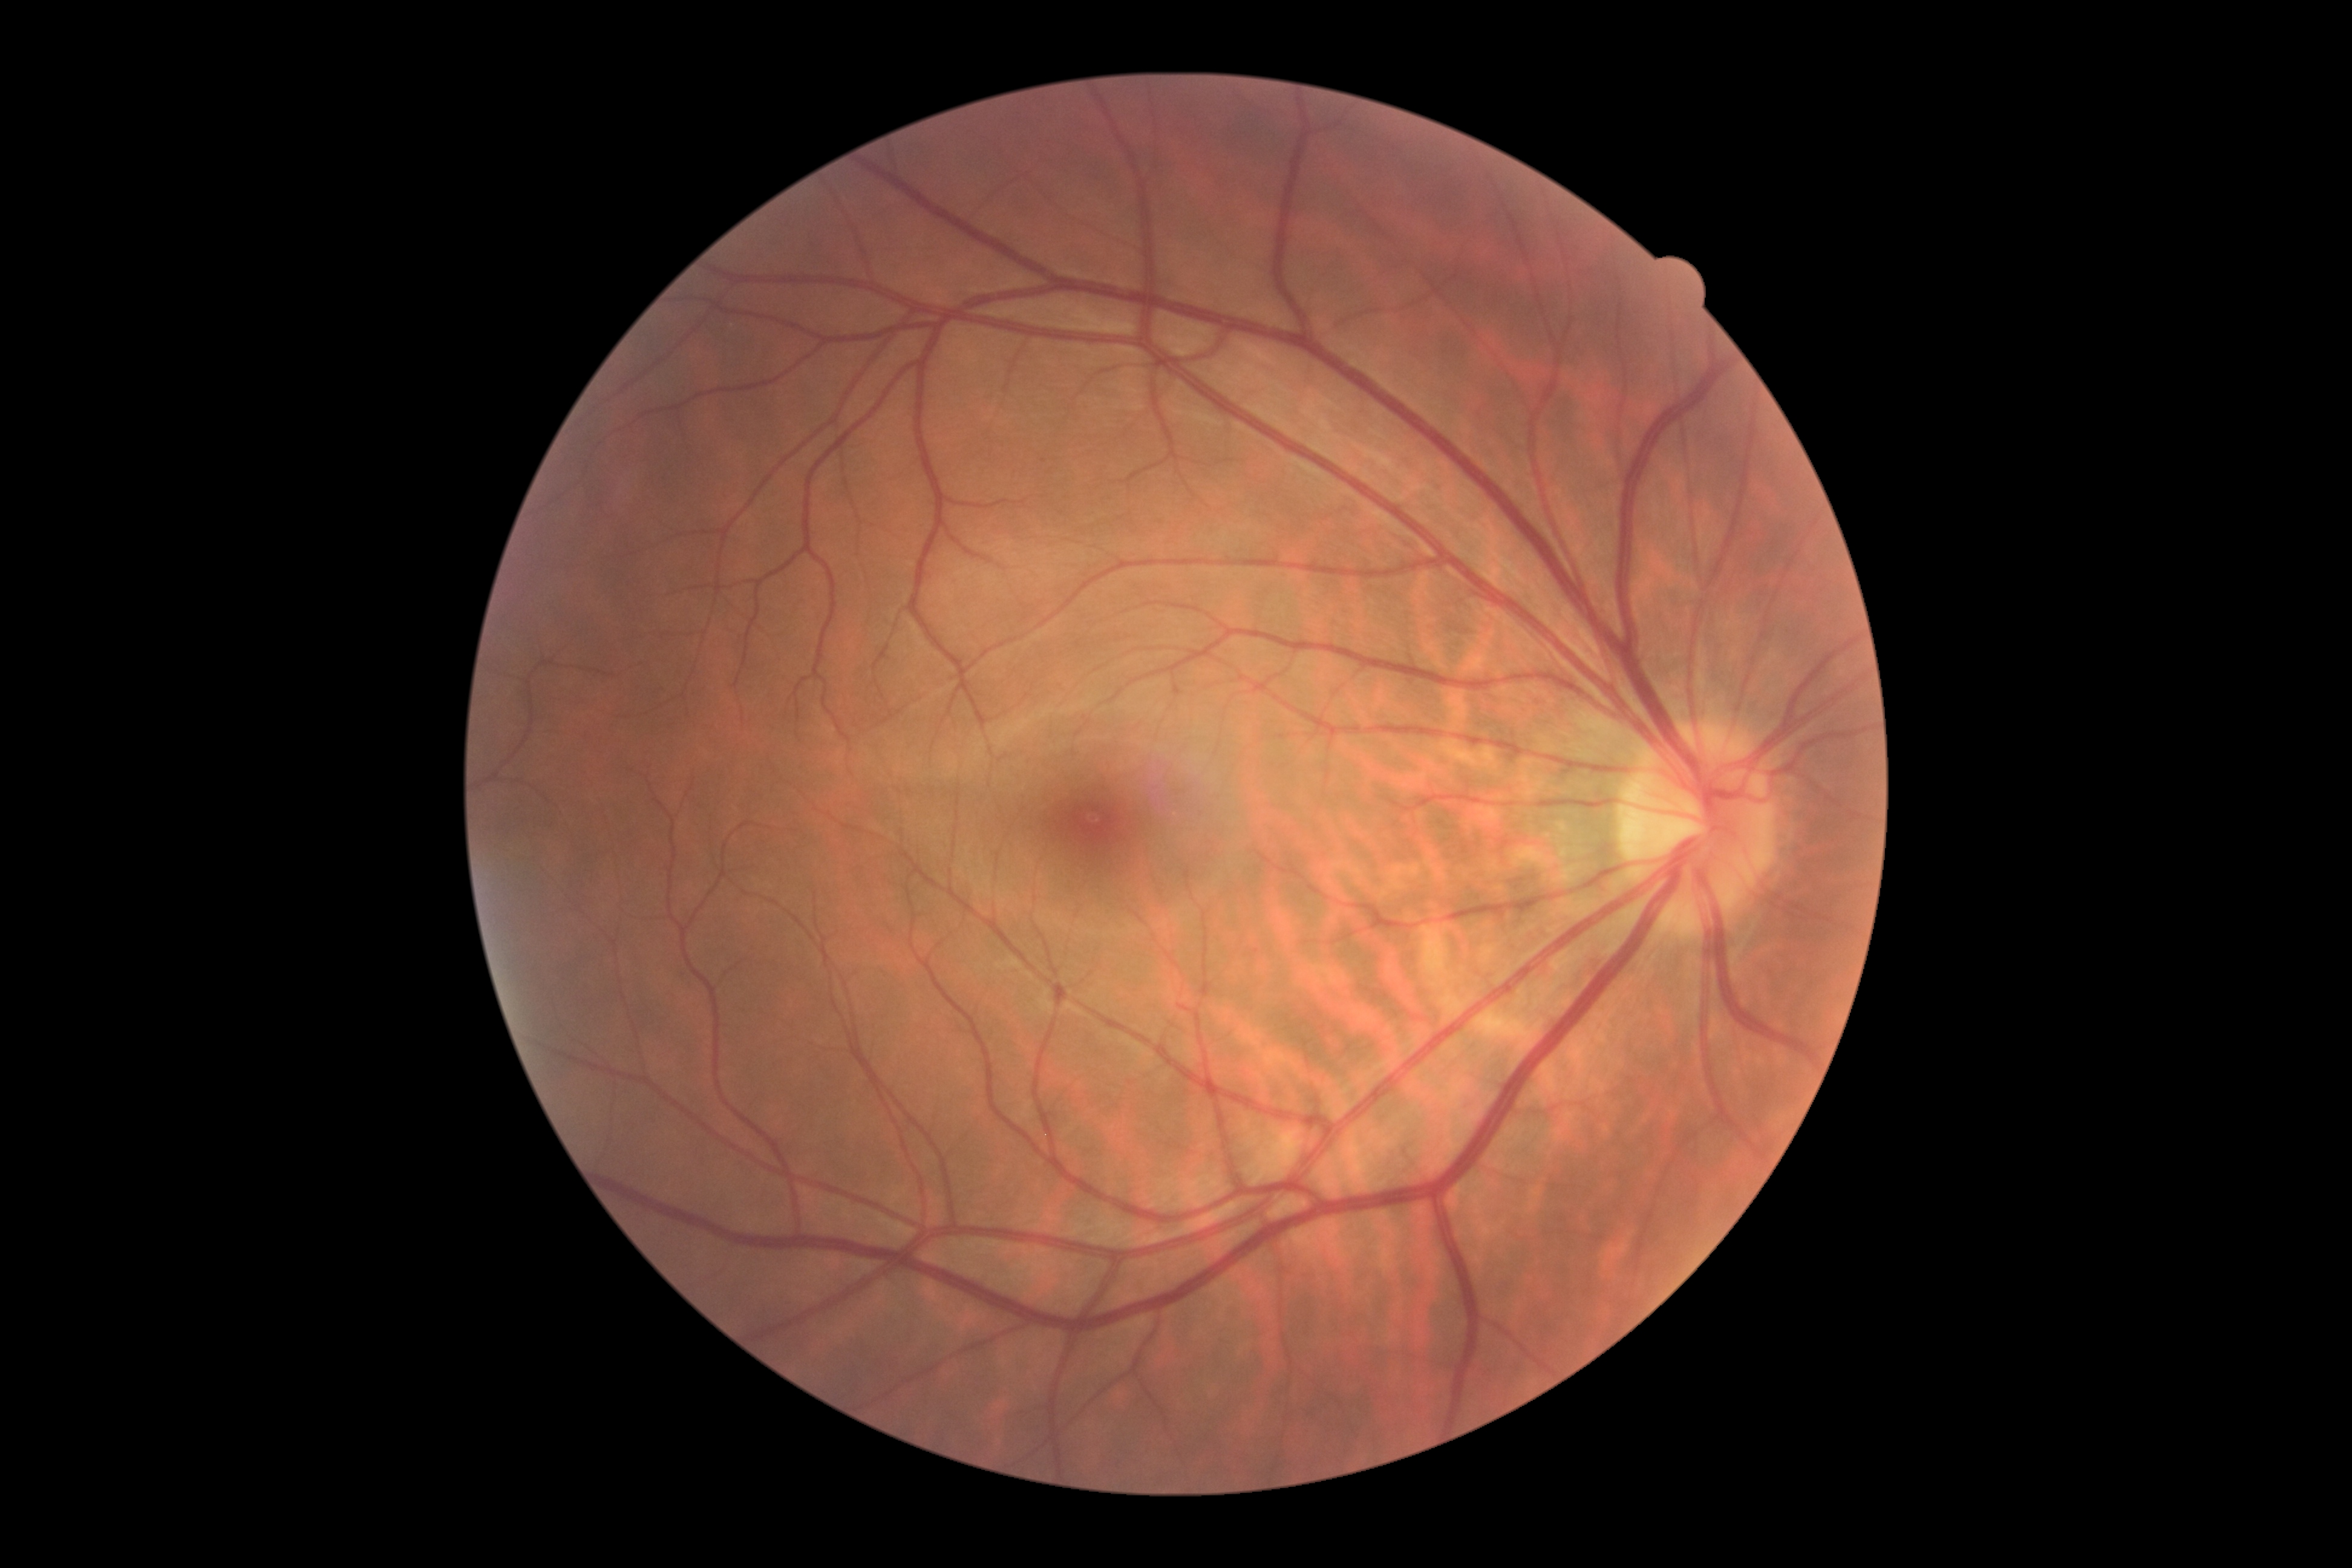

DR is 0. No diabetic retinal disease findings.